Wide-field fundus photograph of an infant
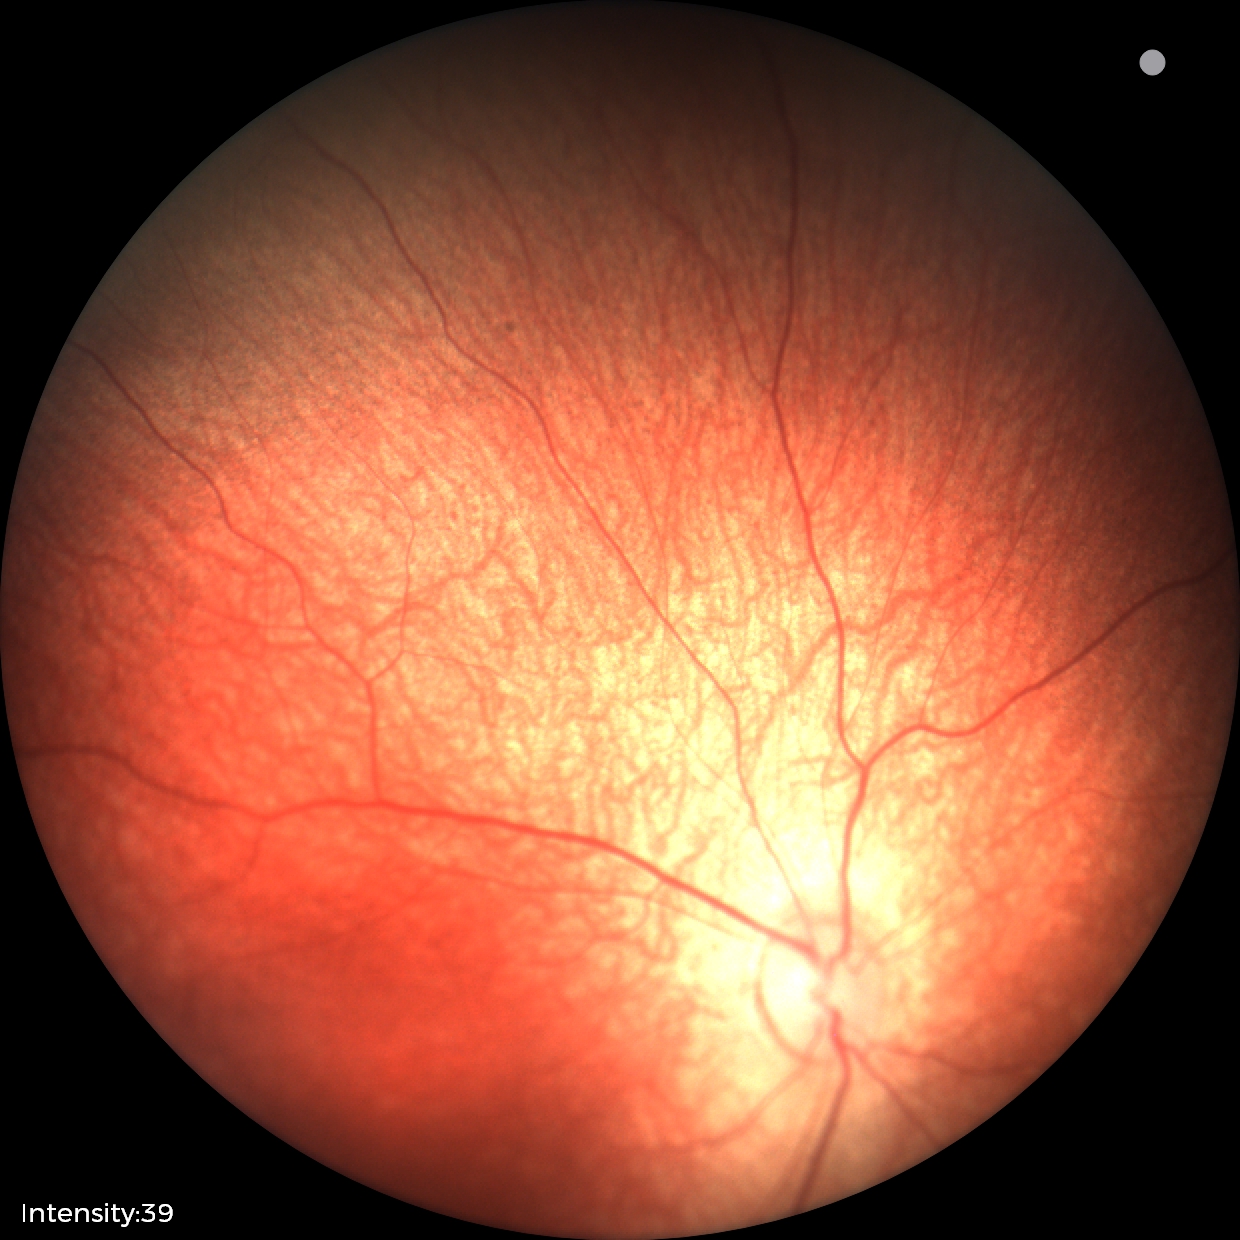
Examination with physiological retinal findings.